Phoenix ICON wide-field infant fundus image.
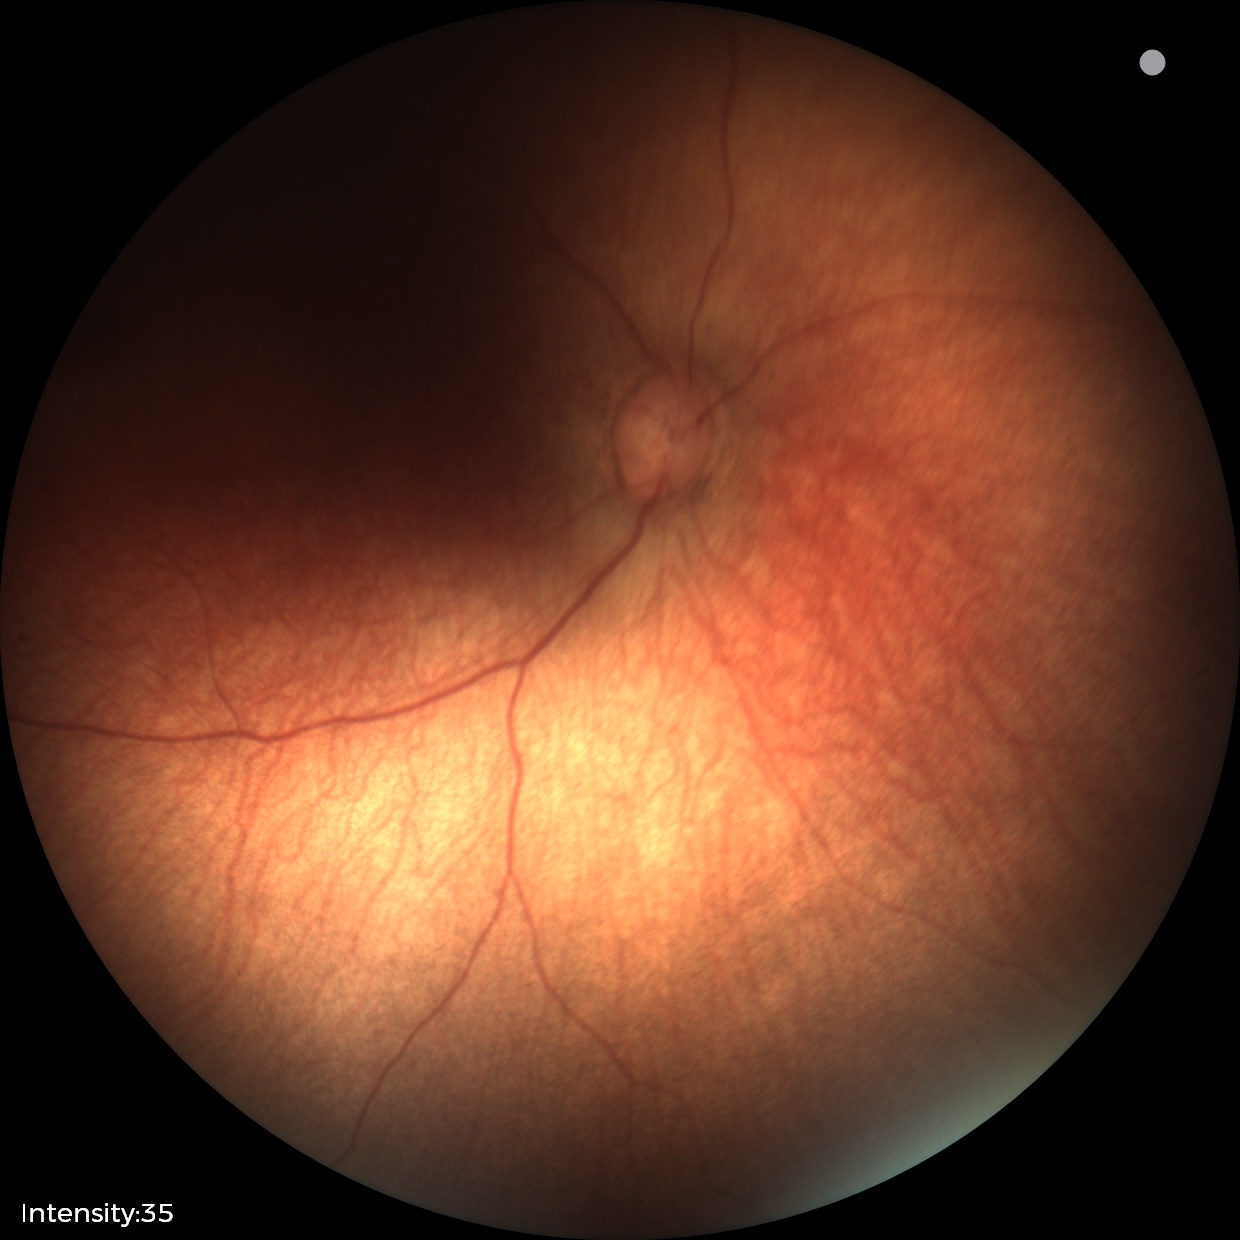
Physiological retinal appearance for postconceptual age.